2184 by 1682 pixels
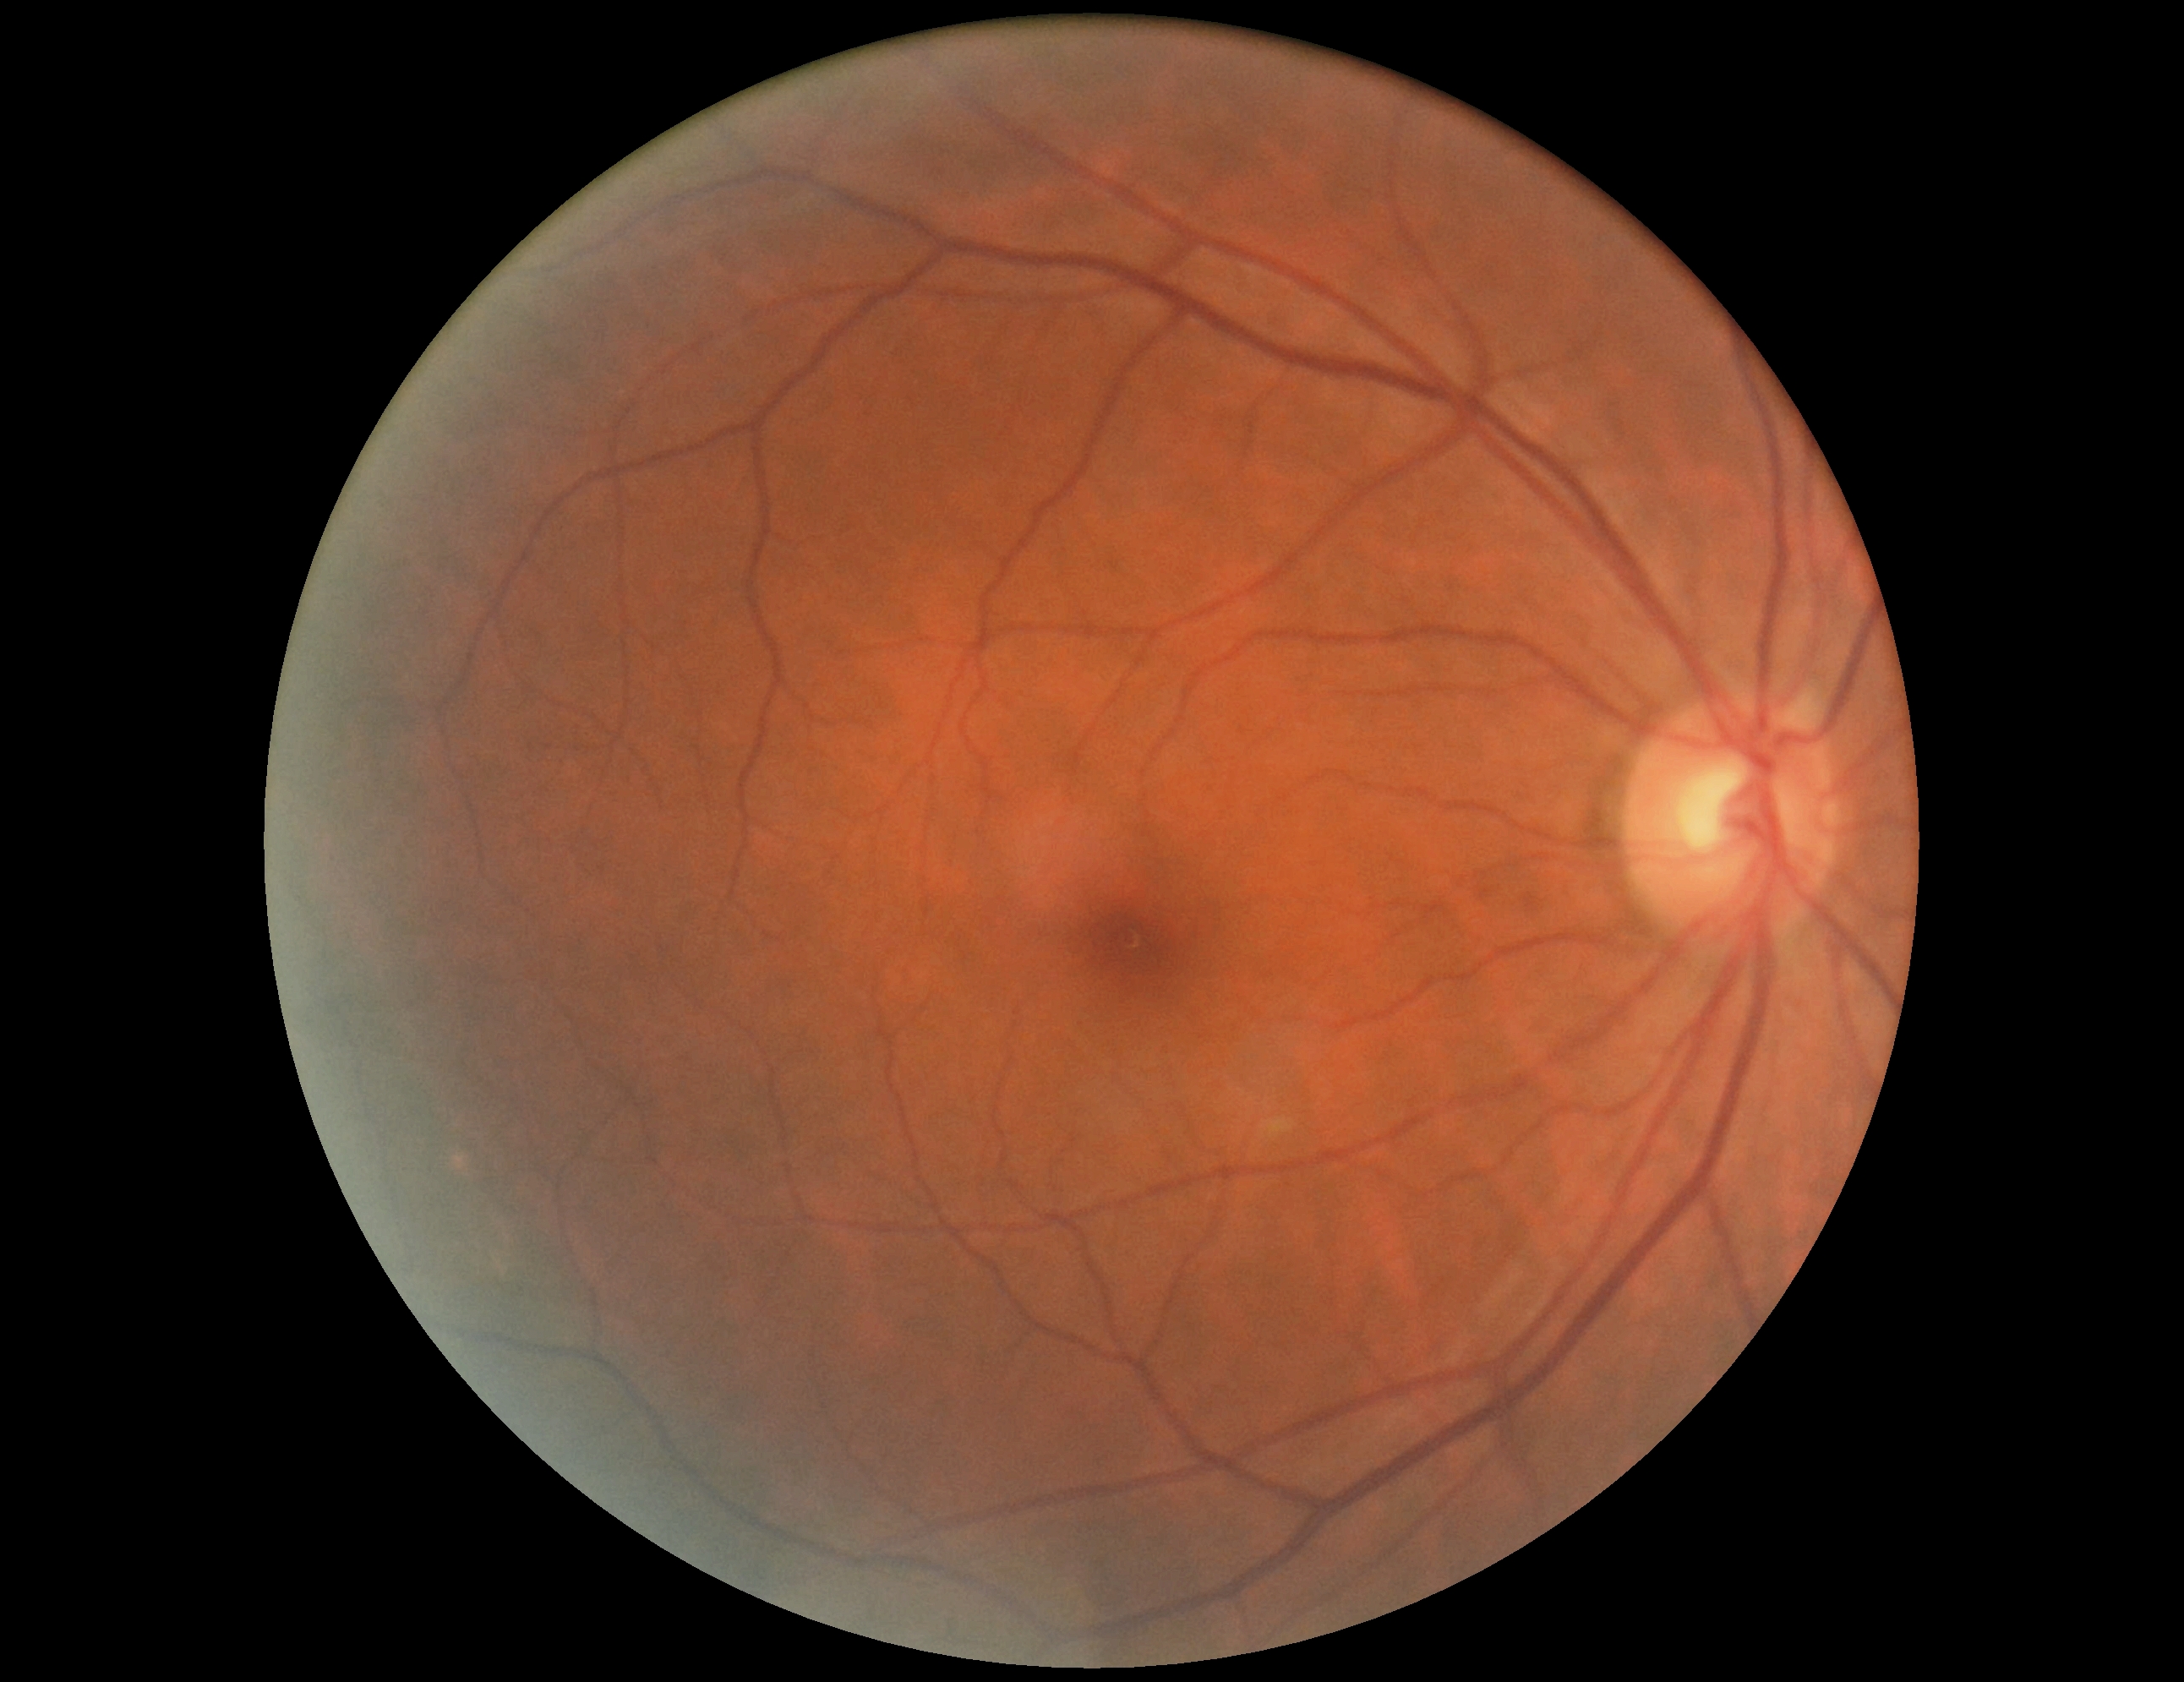

retinopathy=grade 0 — no visible signs of diabetic retinopathy.